Color fundus image; NIDEK AFC-230: 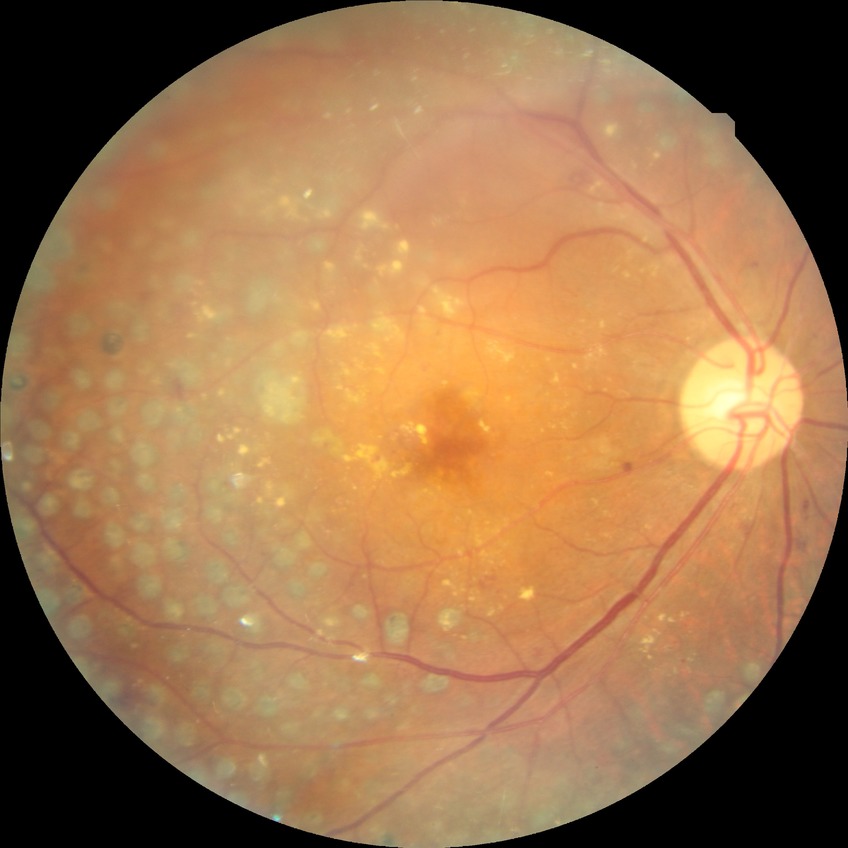
Davis grade: PDR.